2048x1536, 45-degree field of view, CFP — 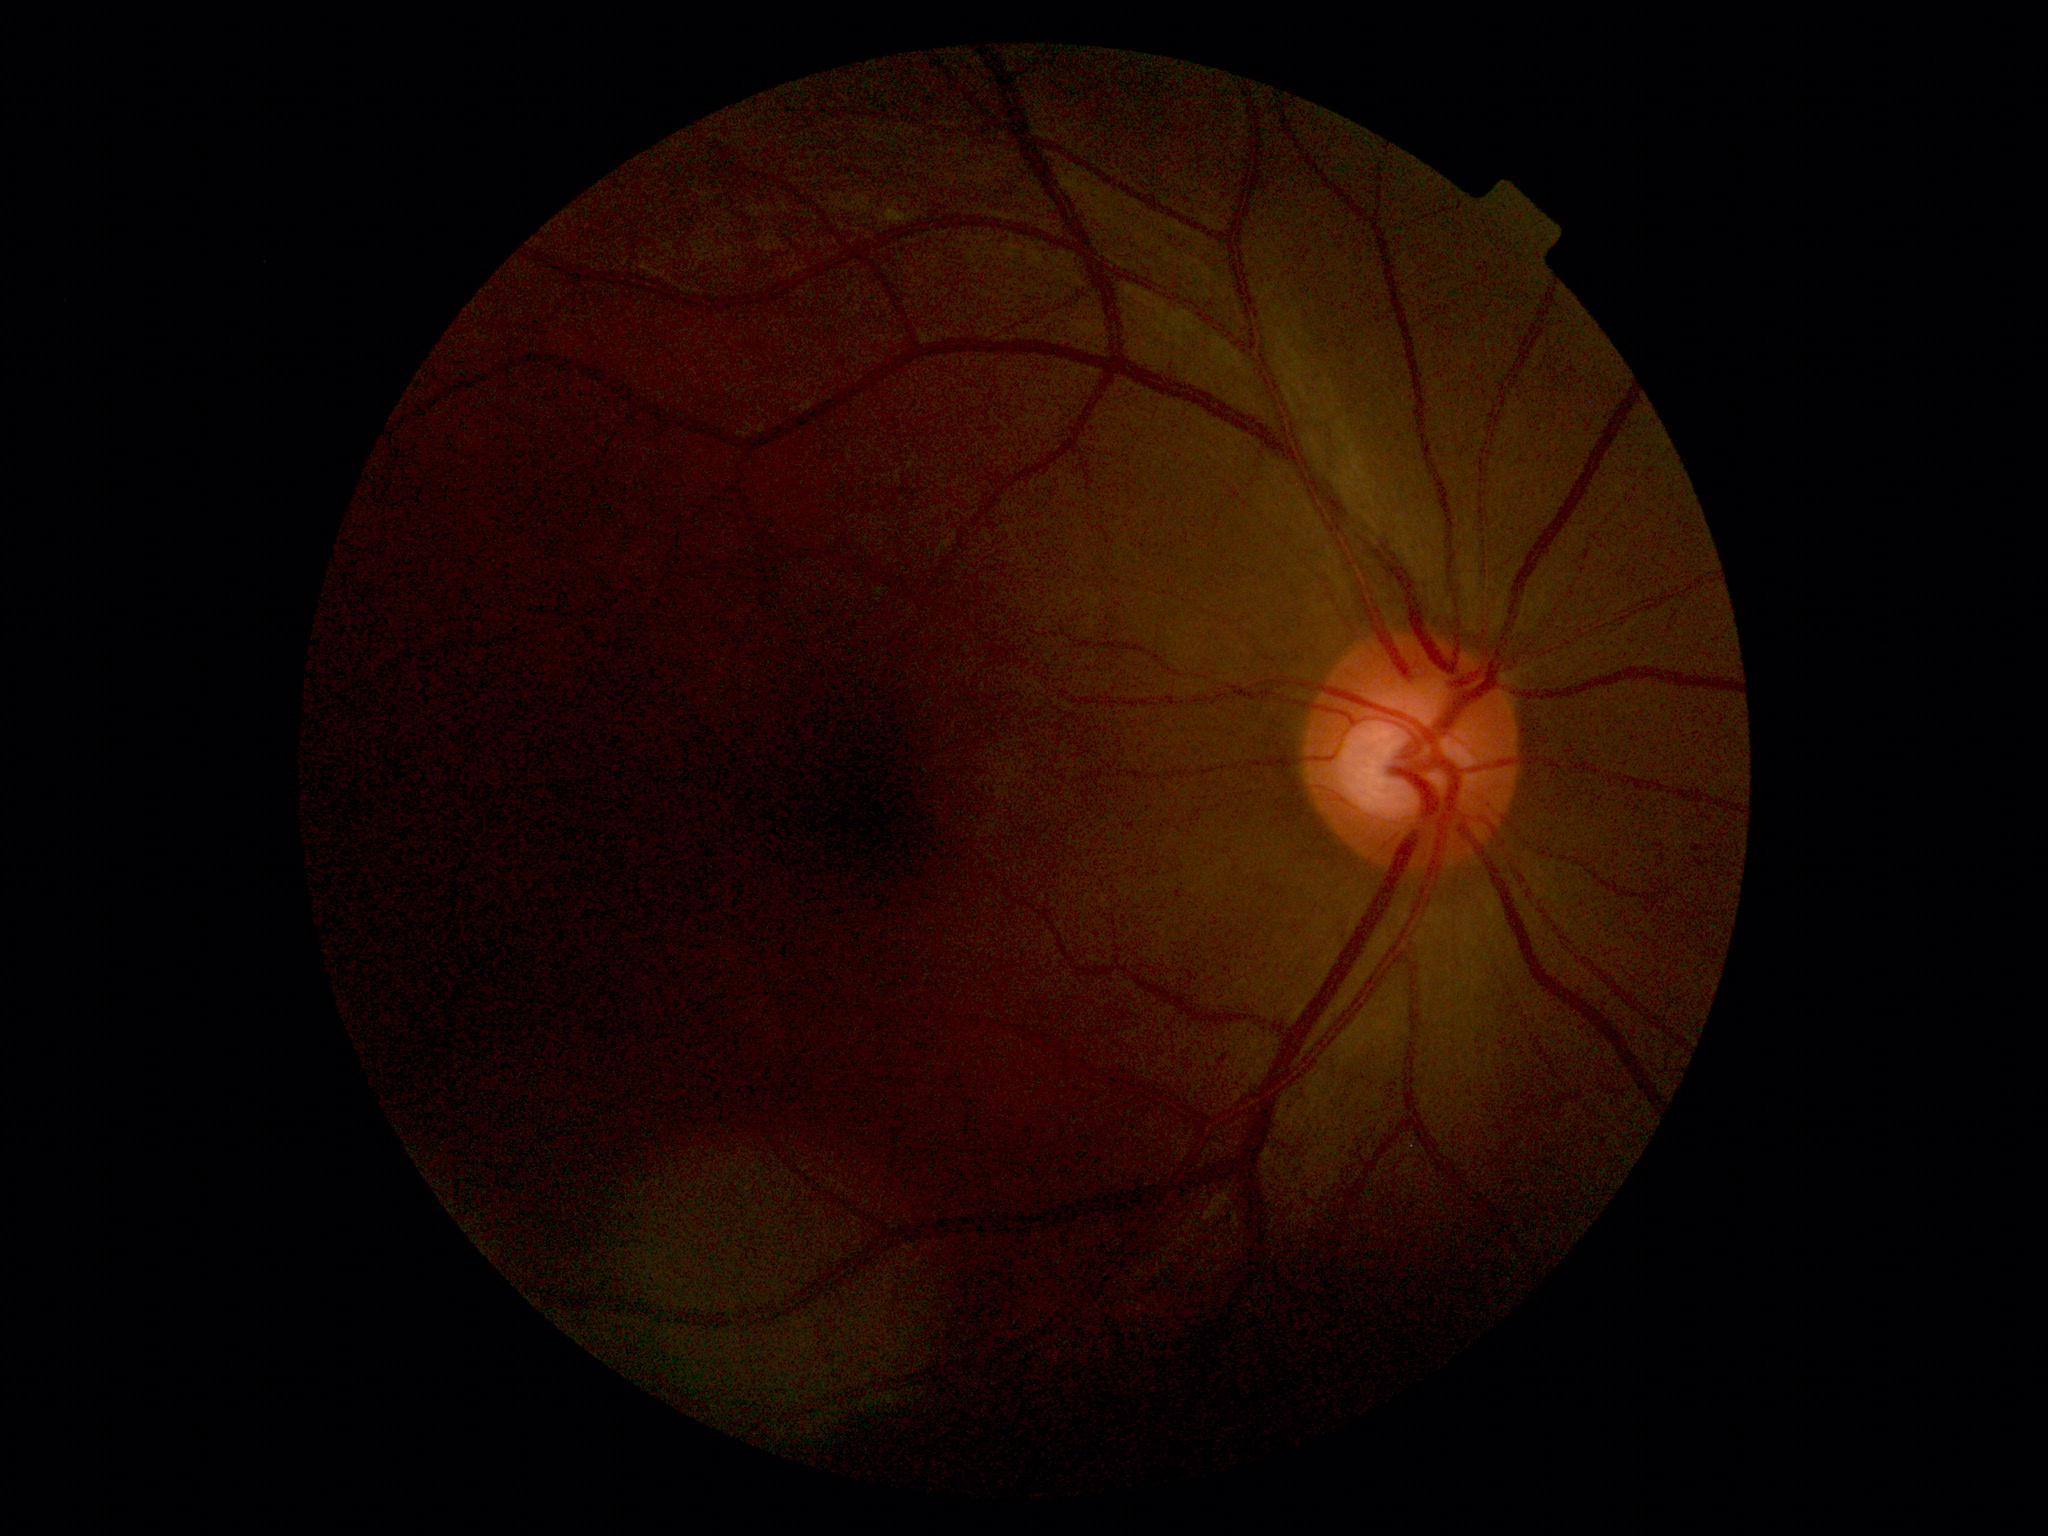

No diabetic retinal disease findings. Diabetic retinopathy severity is grade 0 — no visible signs of diabetic retinopathy.